1240x1240px. Infant wide-field retinal image: 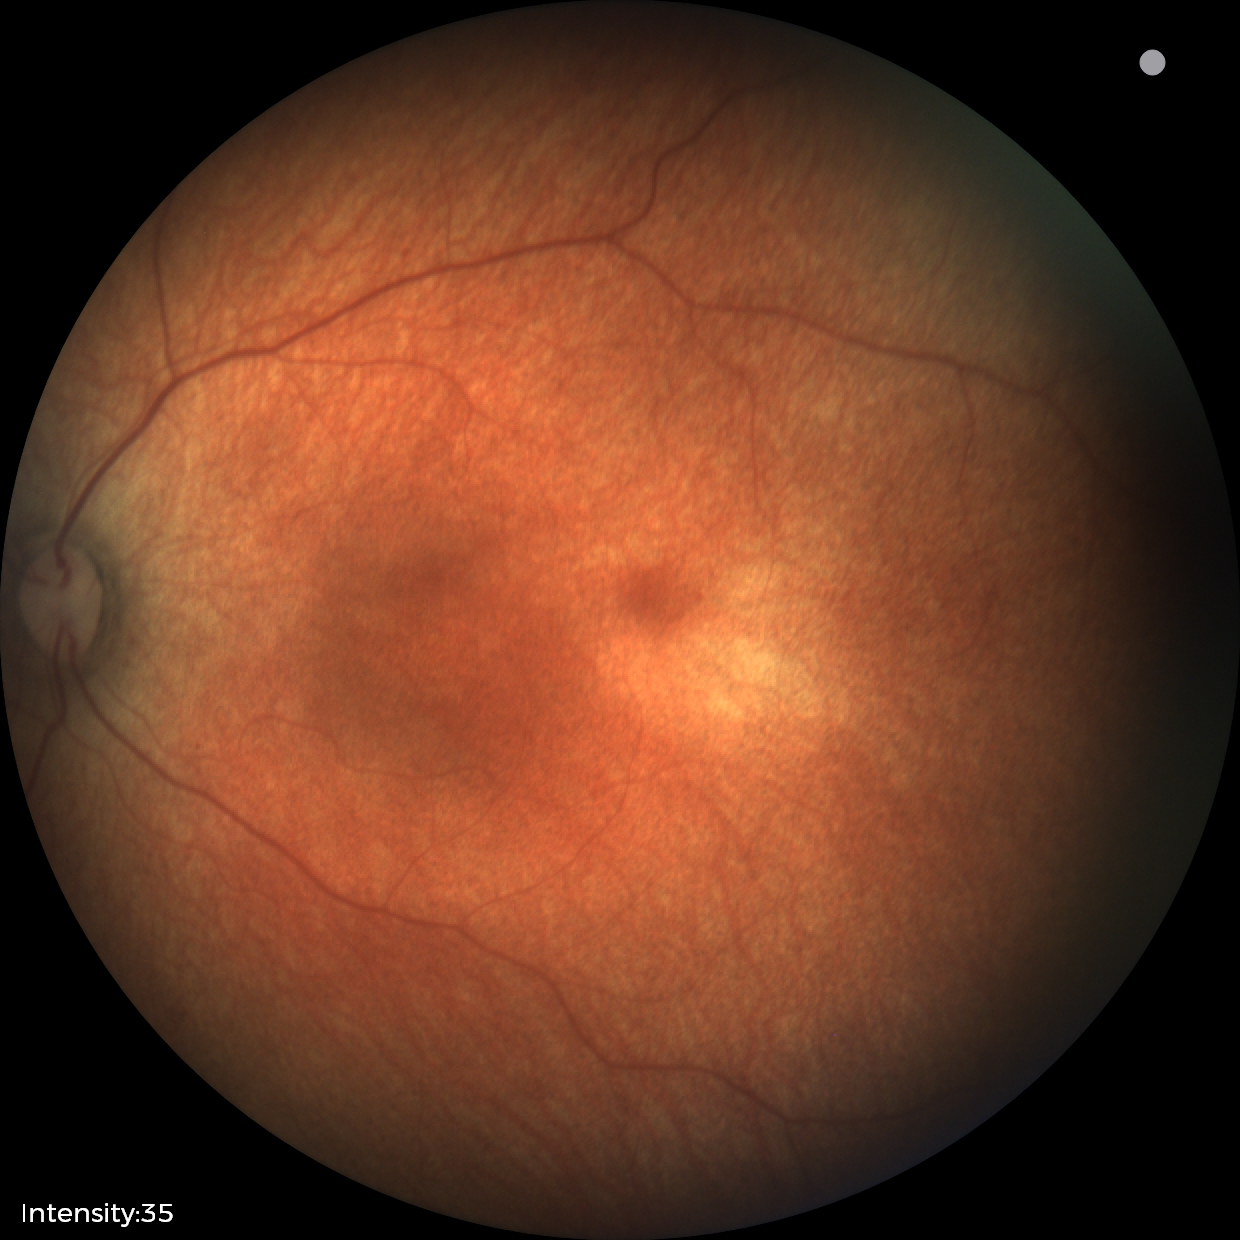
Screening diagnosis: no abnormal retinal findings.